FOV: 45 degrees.
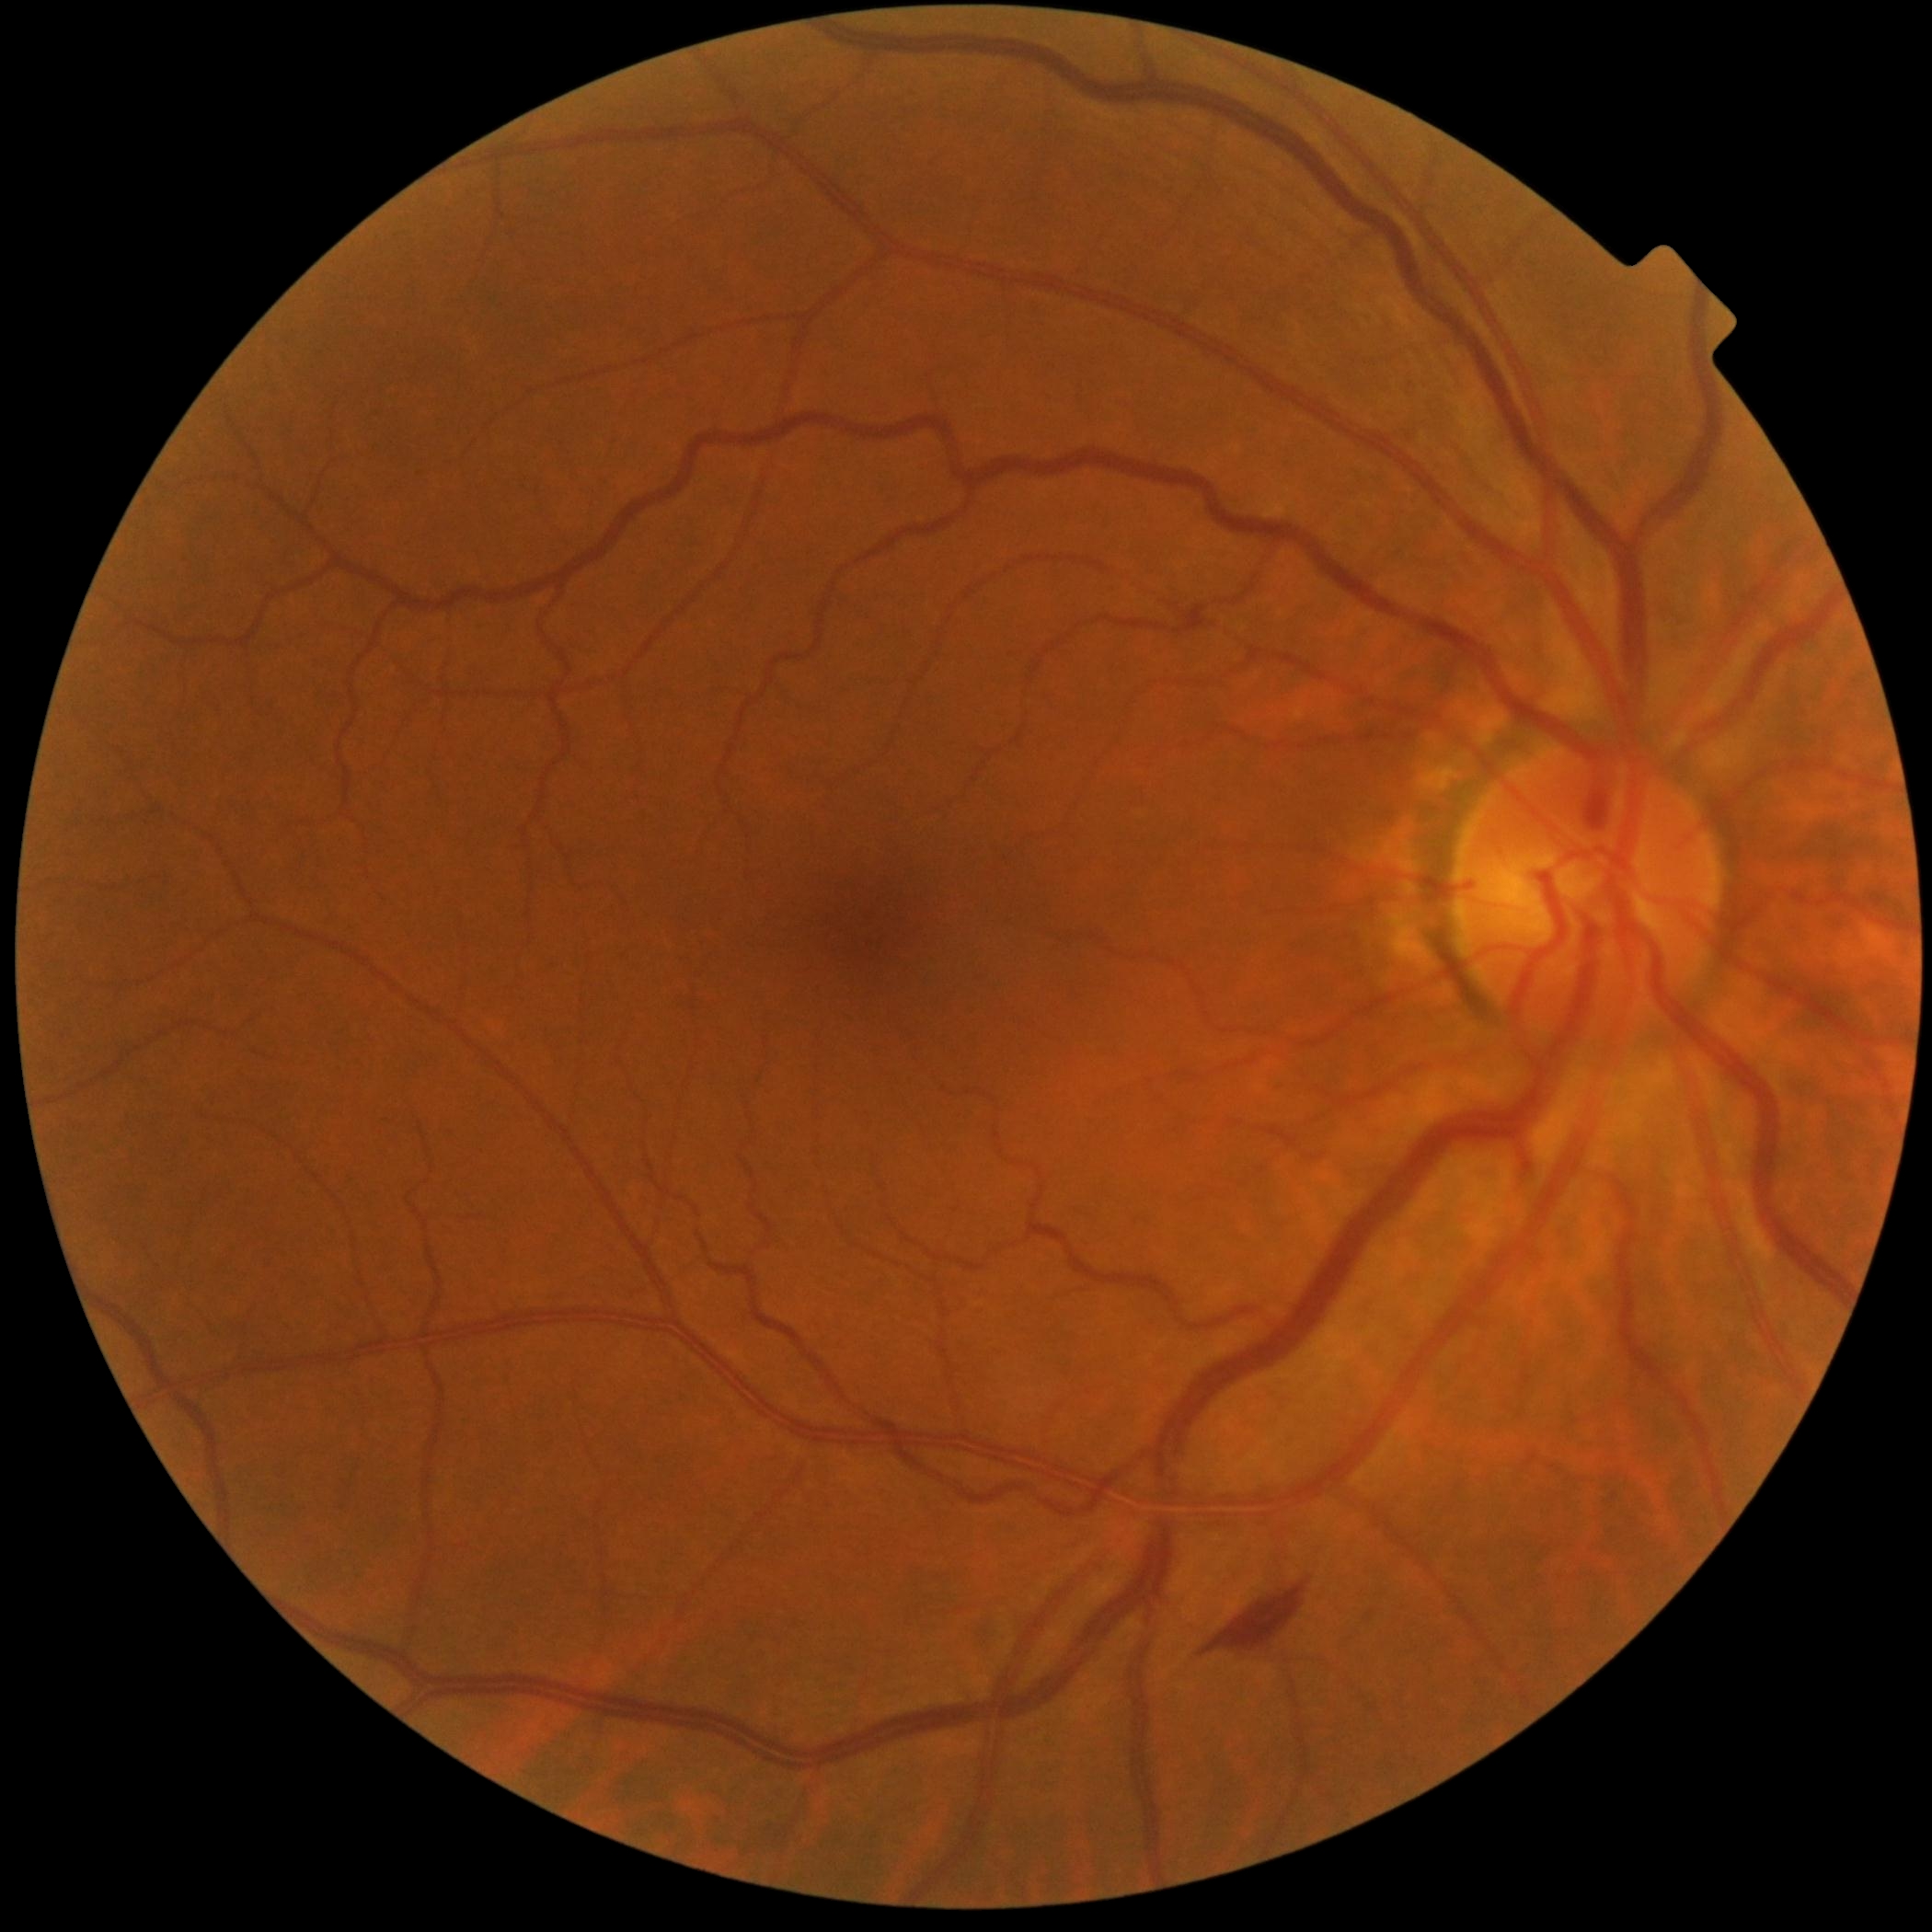

DR severity is 2/4.